Non-mydriatic acquisition · captured on a Nidek AFC-330 fundus camera
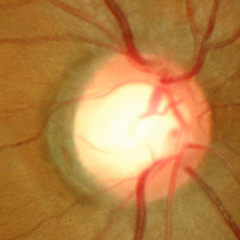

No glaucomatous changes.